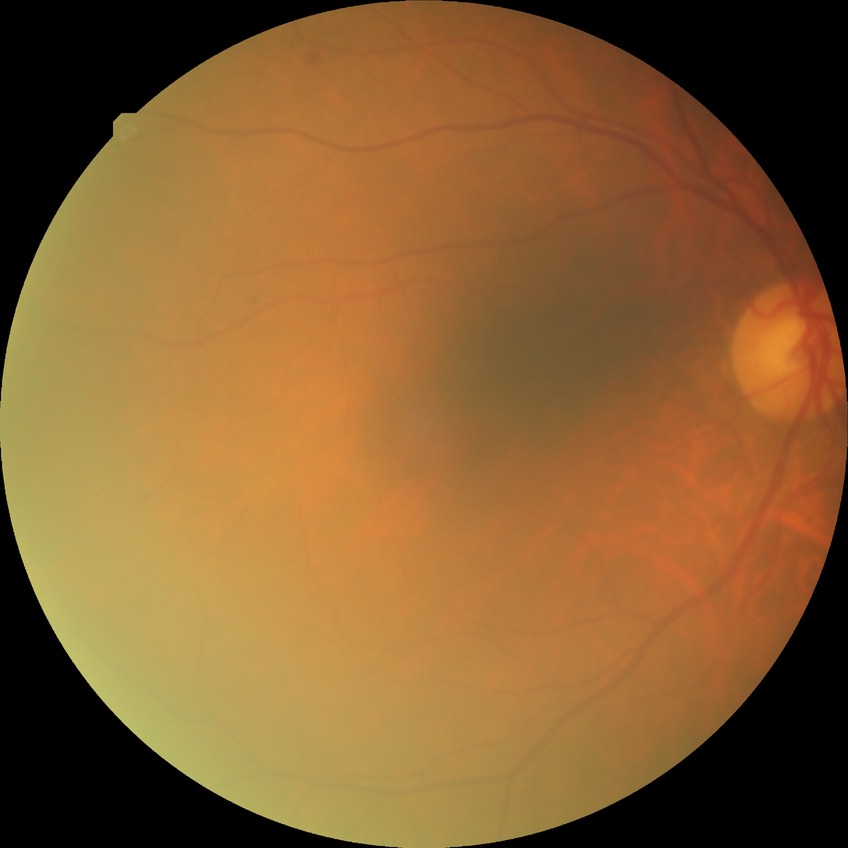

Diabetic retinopathy (DR) is SDR (simple diabetic retinopathy).